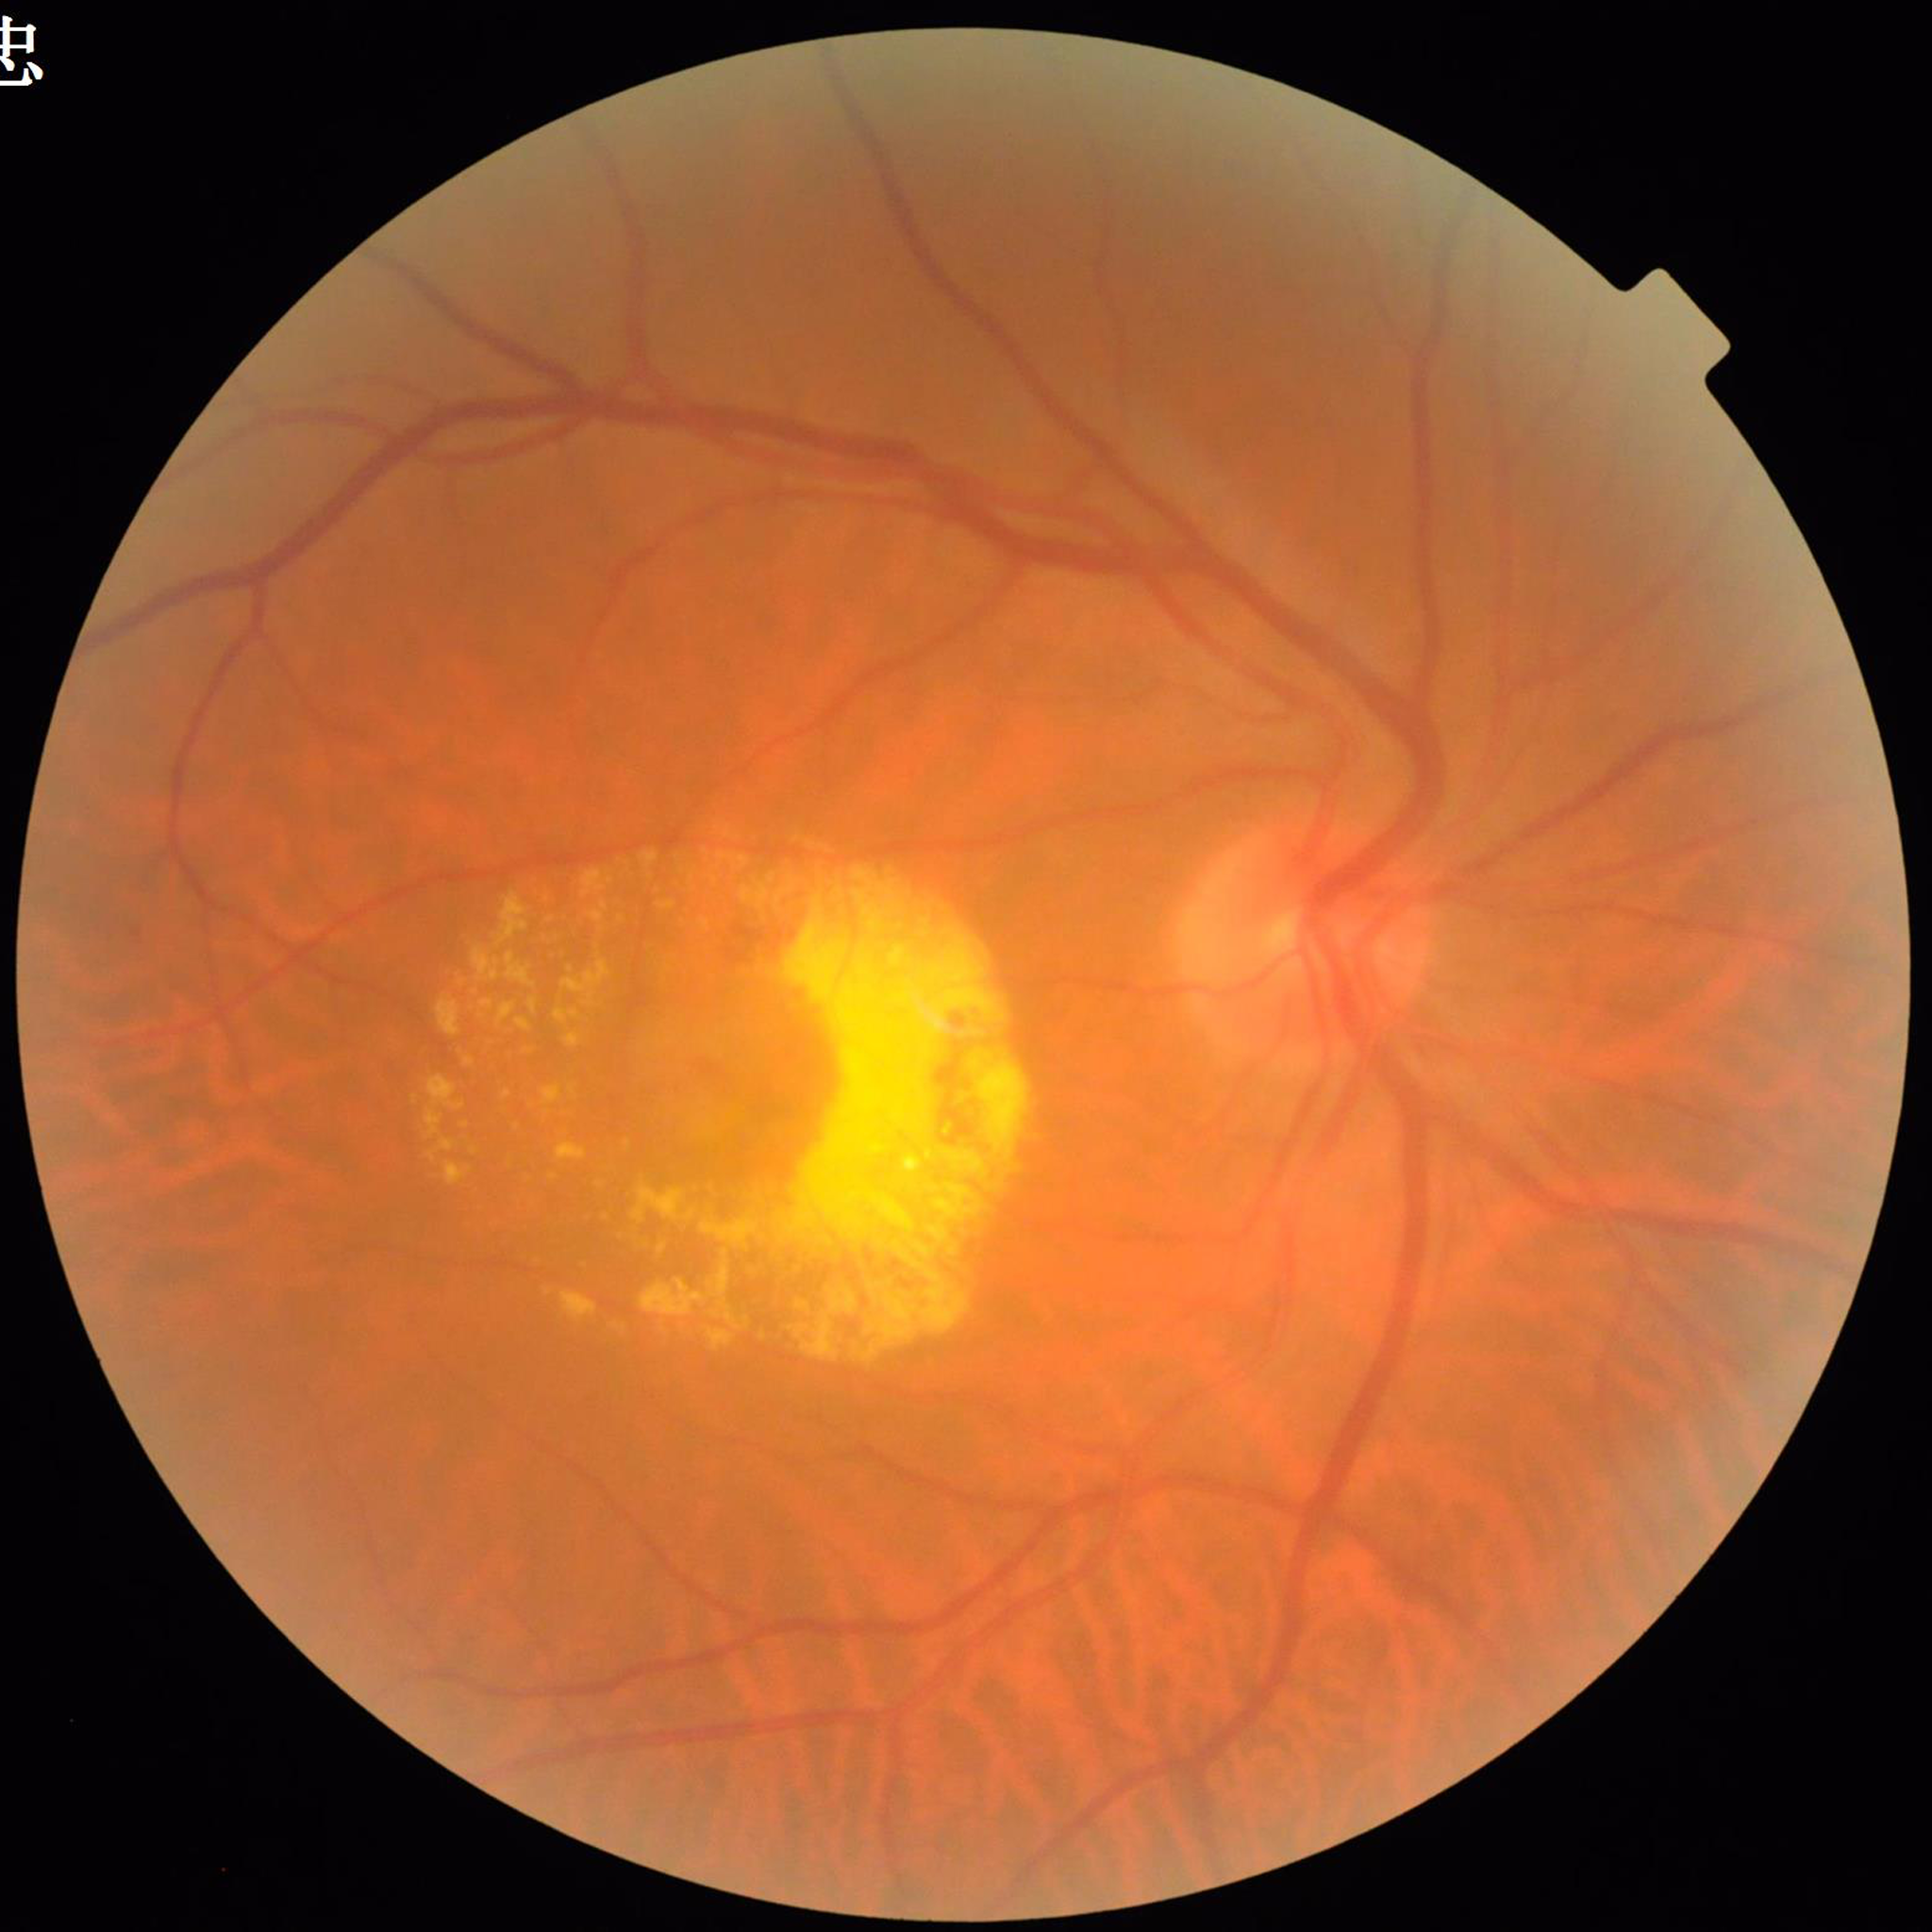
Disease class: AMD